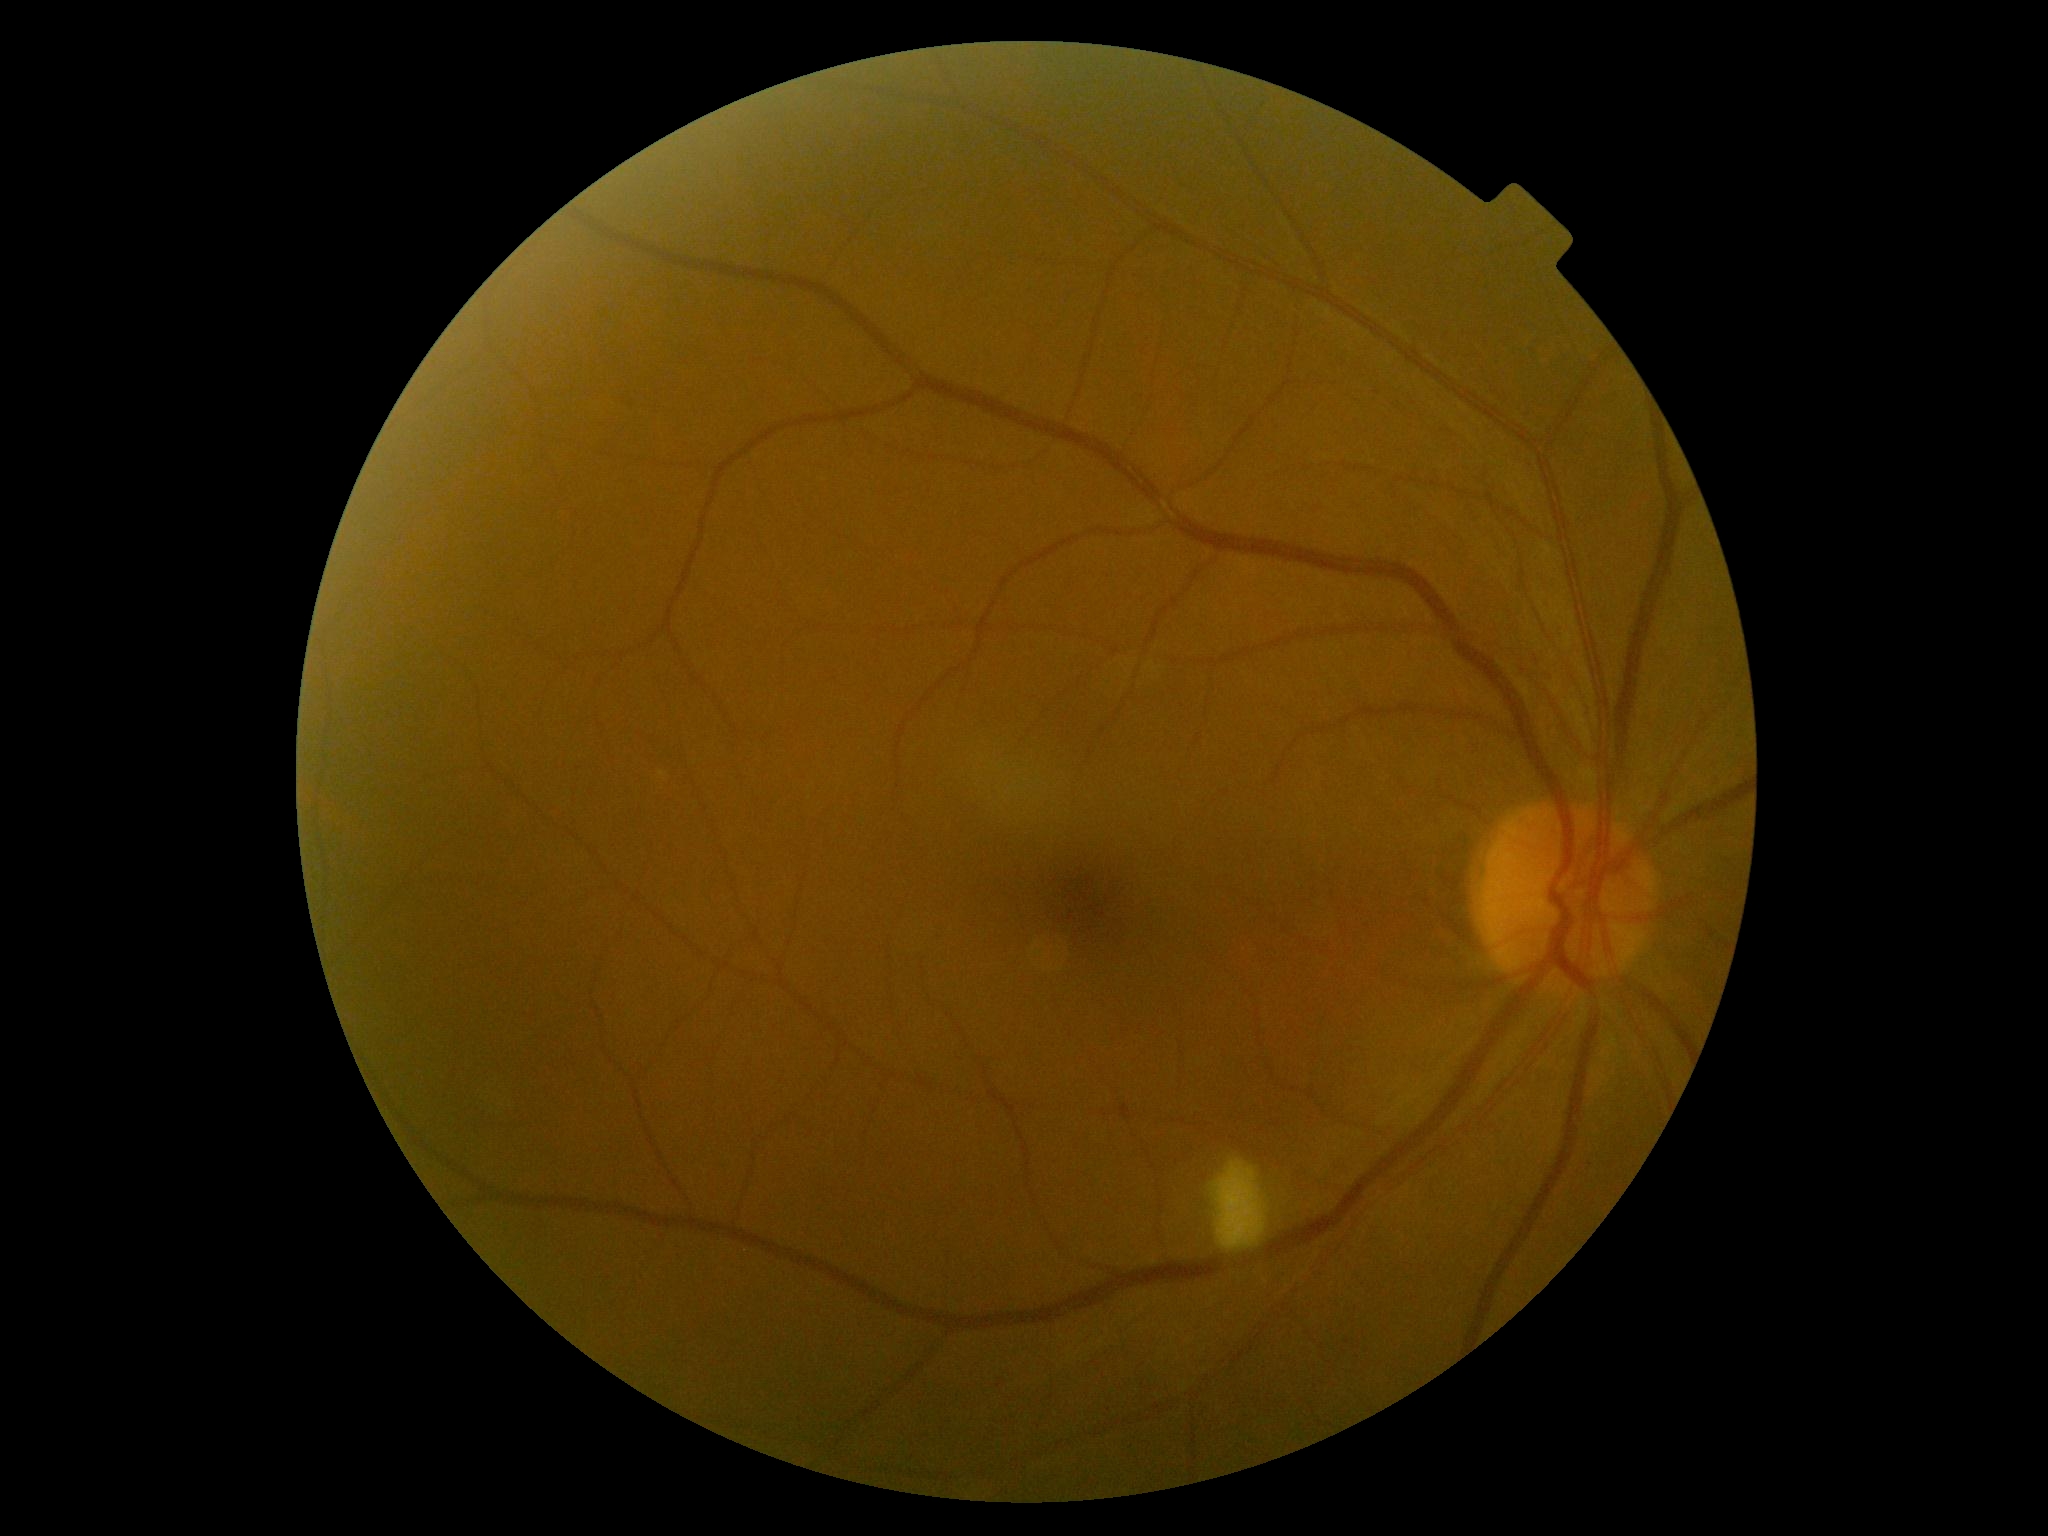
Diabetic retinopathy grade is 2/4.